Image size 2352x1568, color fundus image: 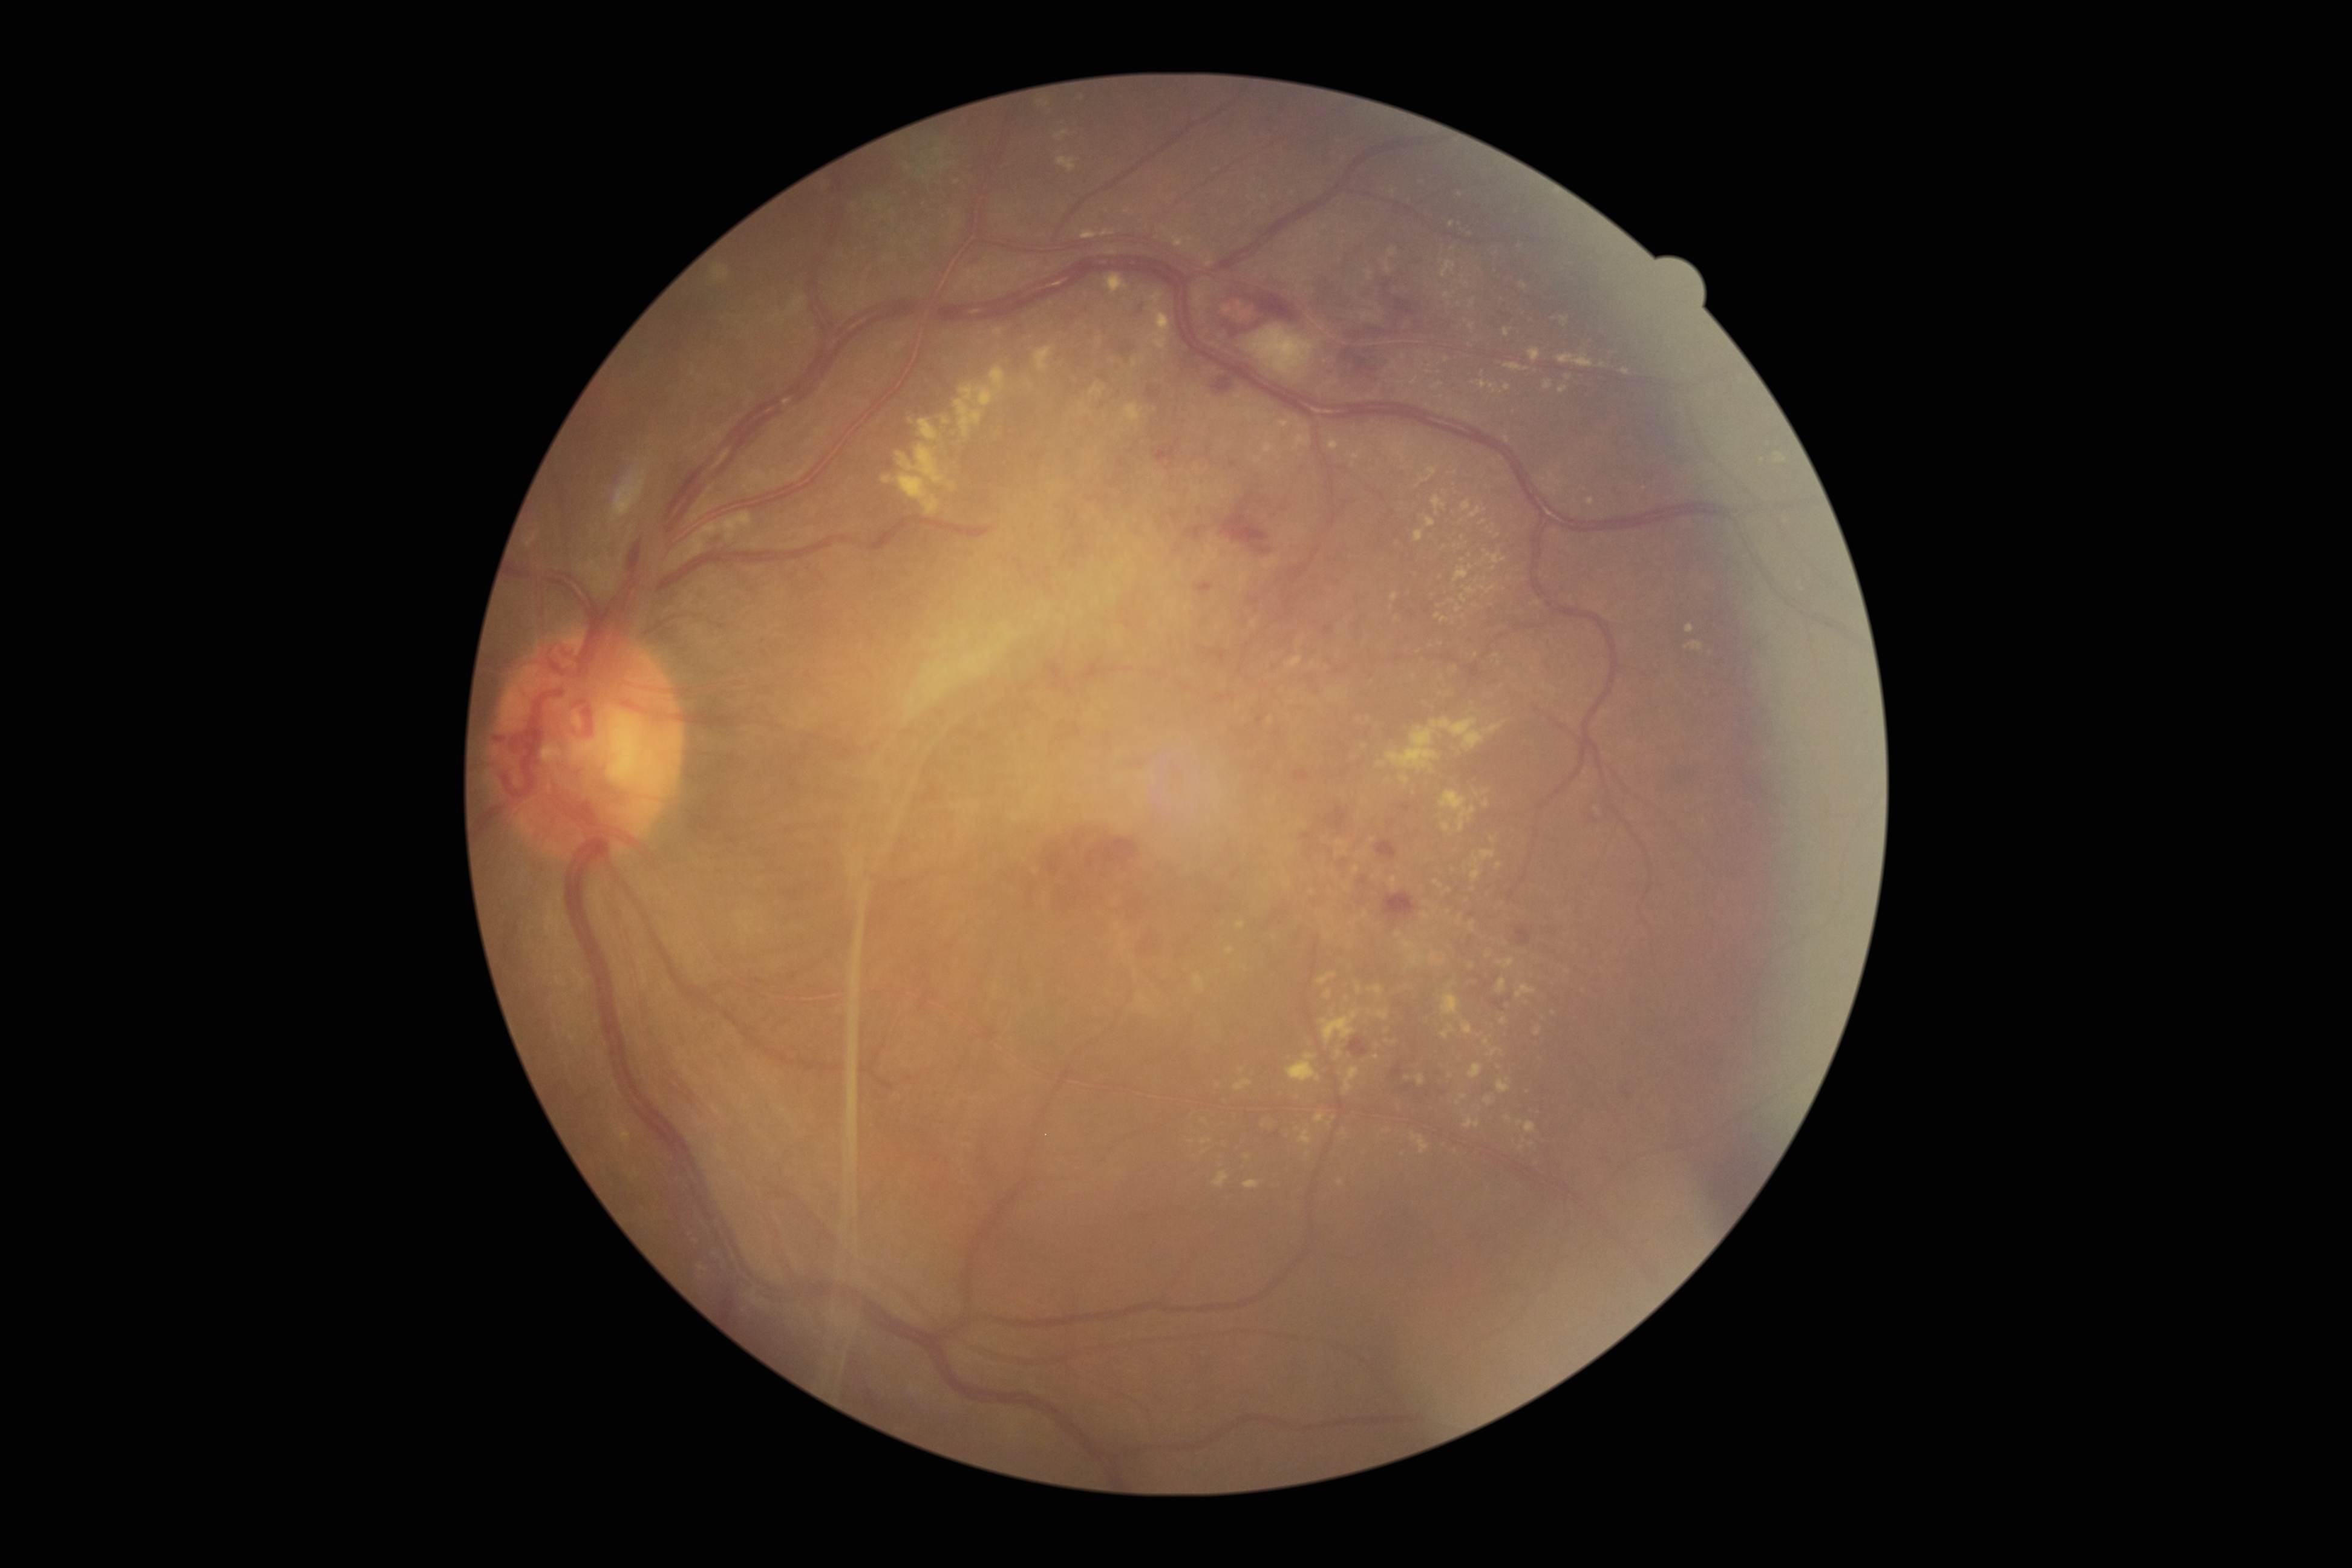 <lesions partial="true">
  <dr_grade>4</dr_grade>
  <ex partial="true">x1=1287 y1=1053 x2=1321 y2=1082, x1=1417 y1=469 x2=1438 y2=488, x1=1213 y1=1172 x2=1230 y2=1186, x1=1457 y1=915 x2=1463 y2=924, x1=1534 y1=1027 x2=1542 y2=1036, x1=1081 y1=230 x2=1098 y2=240, x1=1263 y1=557 x2=1279 y2=569, x1=1777 y1=453 x2=1788 y2=463, x1=1686 y1=625 x2=1694 y2=632, x1=1587 y1=498 x2=1595 y2=506, x1=527 y1=534 x2=537 y2=547</ex>
  <ex_small_approx>[1603, 365], [1475, 383], [1441, 398], [1343, 1132], [1287, 884], [1425, 904], [1464, 284], [1470, 568], [1508, 1080]</ex_small_approx>
</lesions>